2352x1568px — 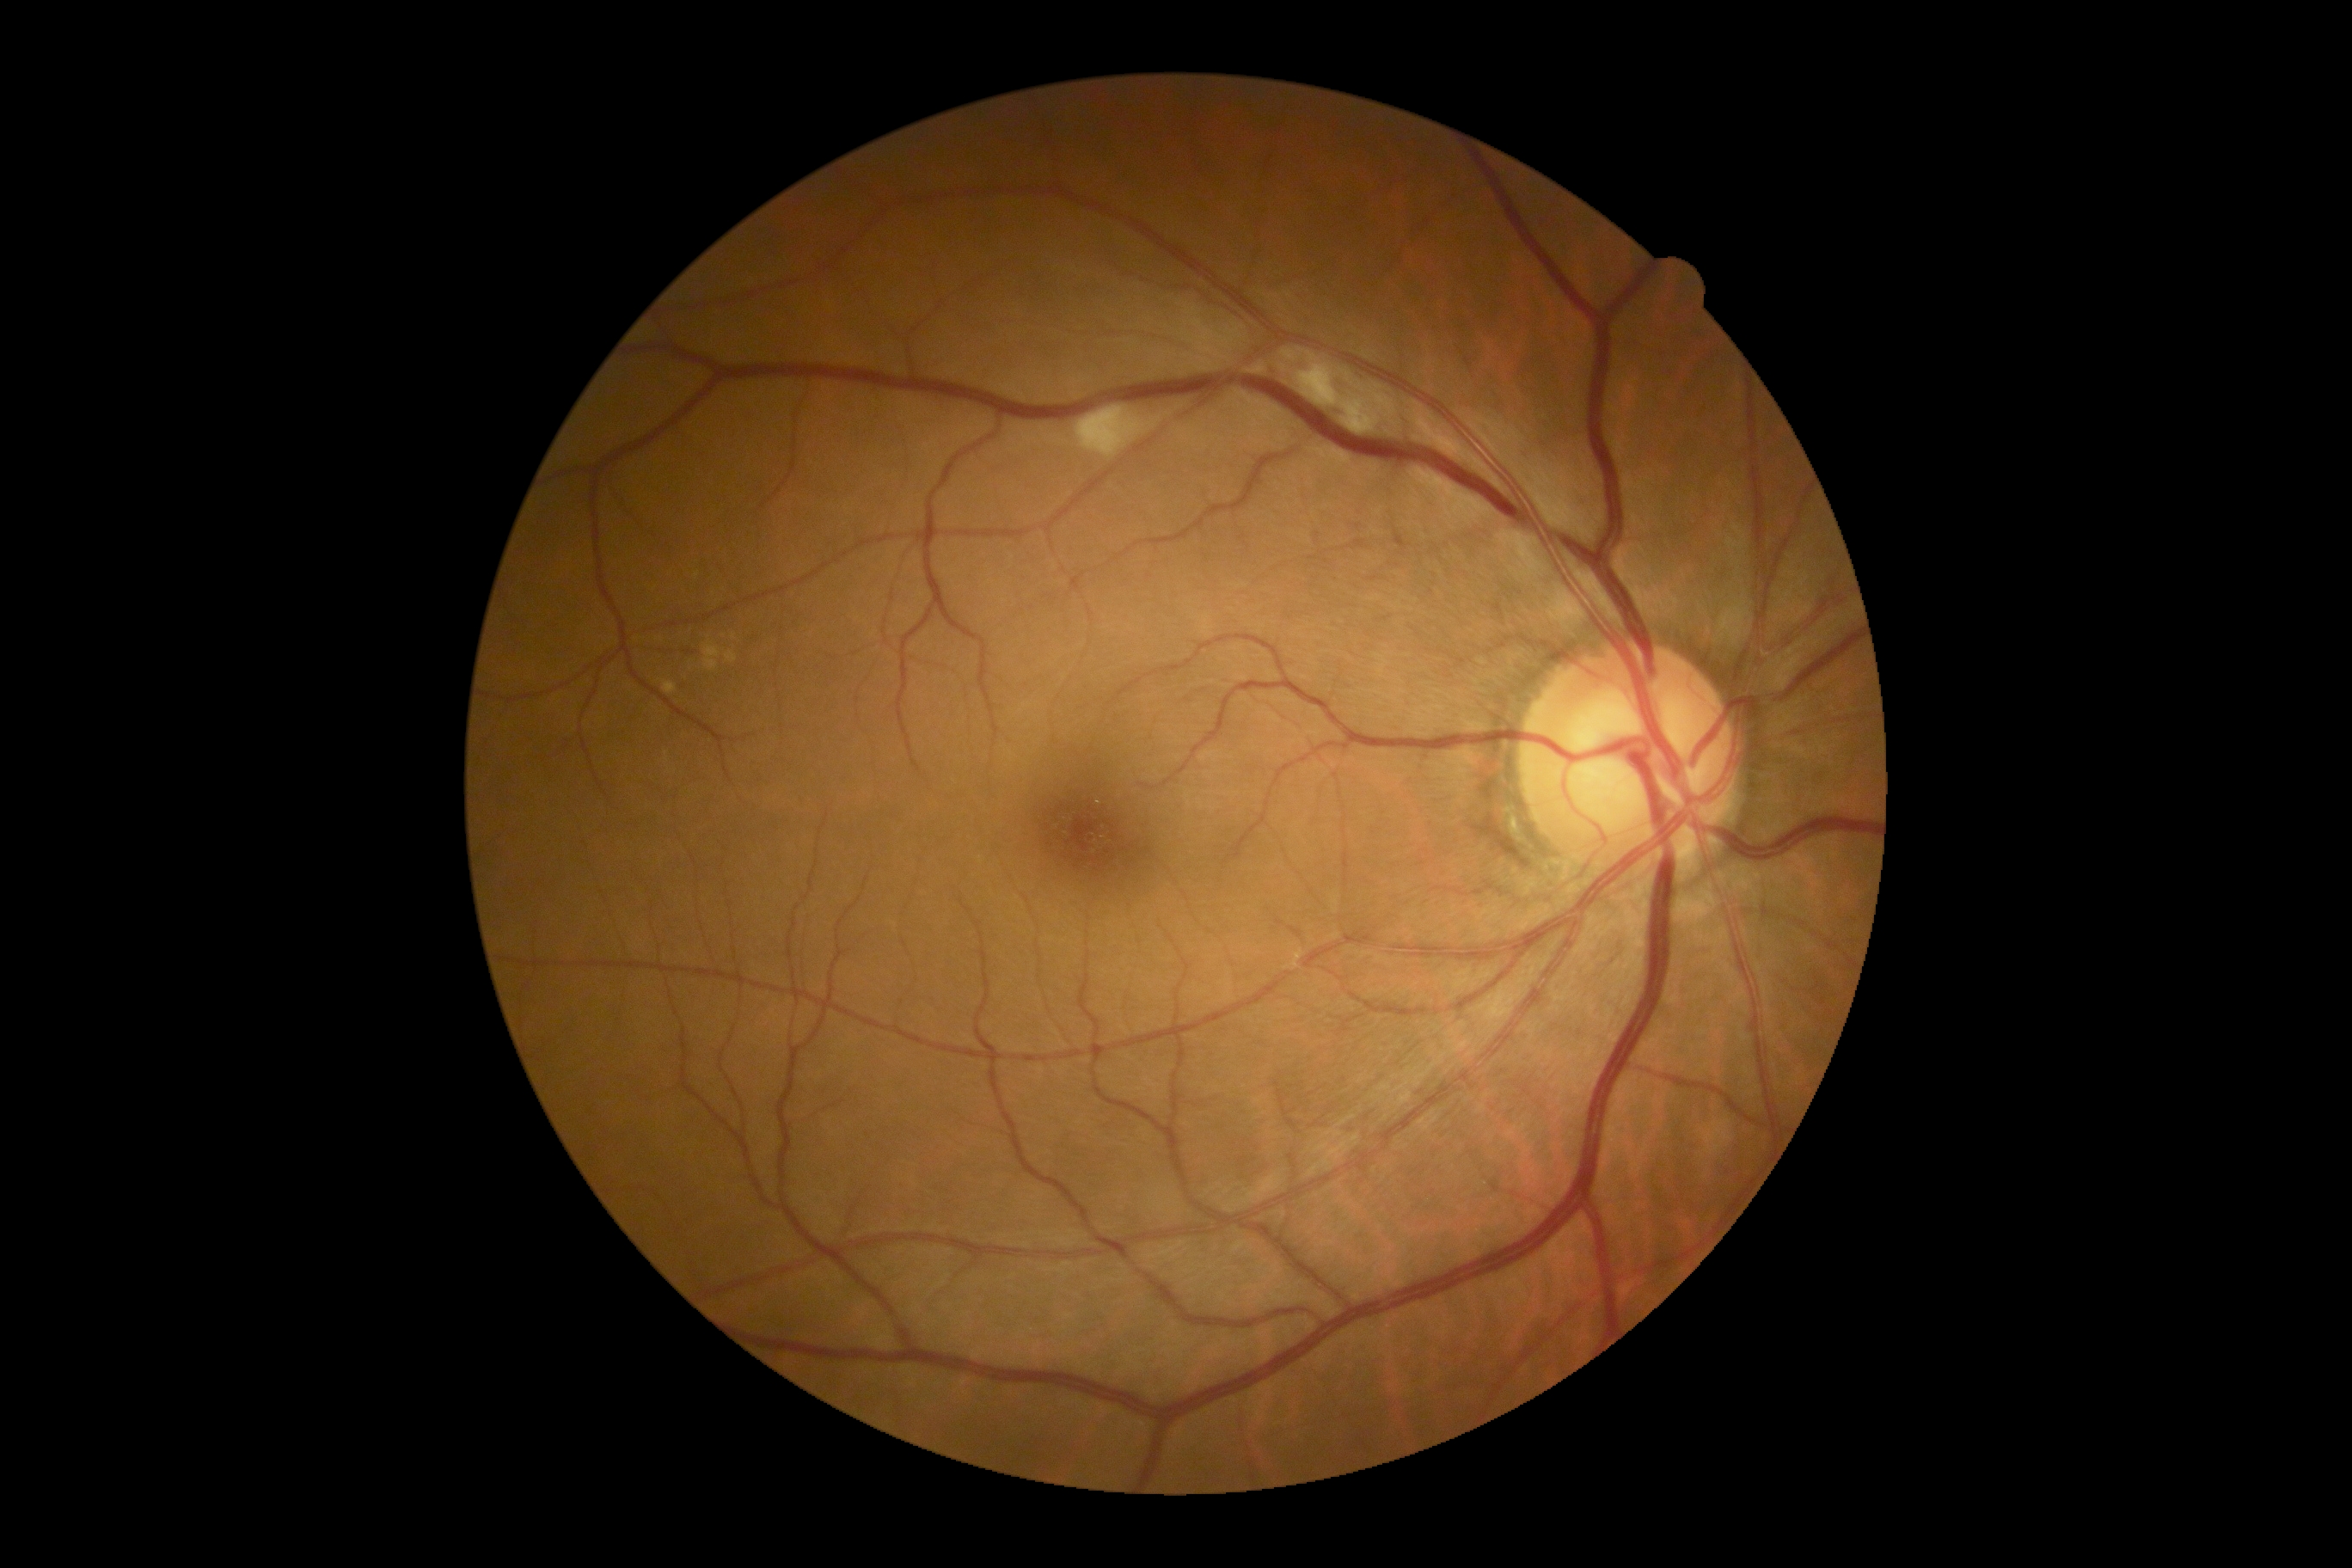 Diabetic retinopathy (DR) is moderate non-proliferative diabetic retinopathy (grade 2).